Acquired with a Nidek AFC-330, fundus photo:
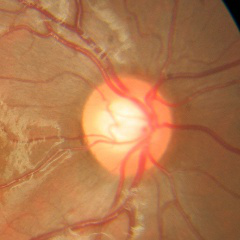
Glaucoma stage = no glaucoma.